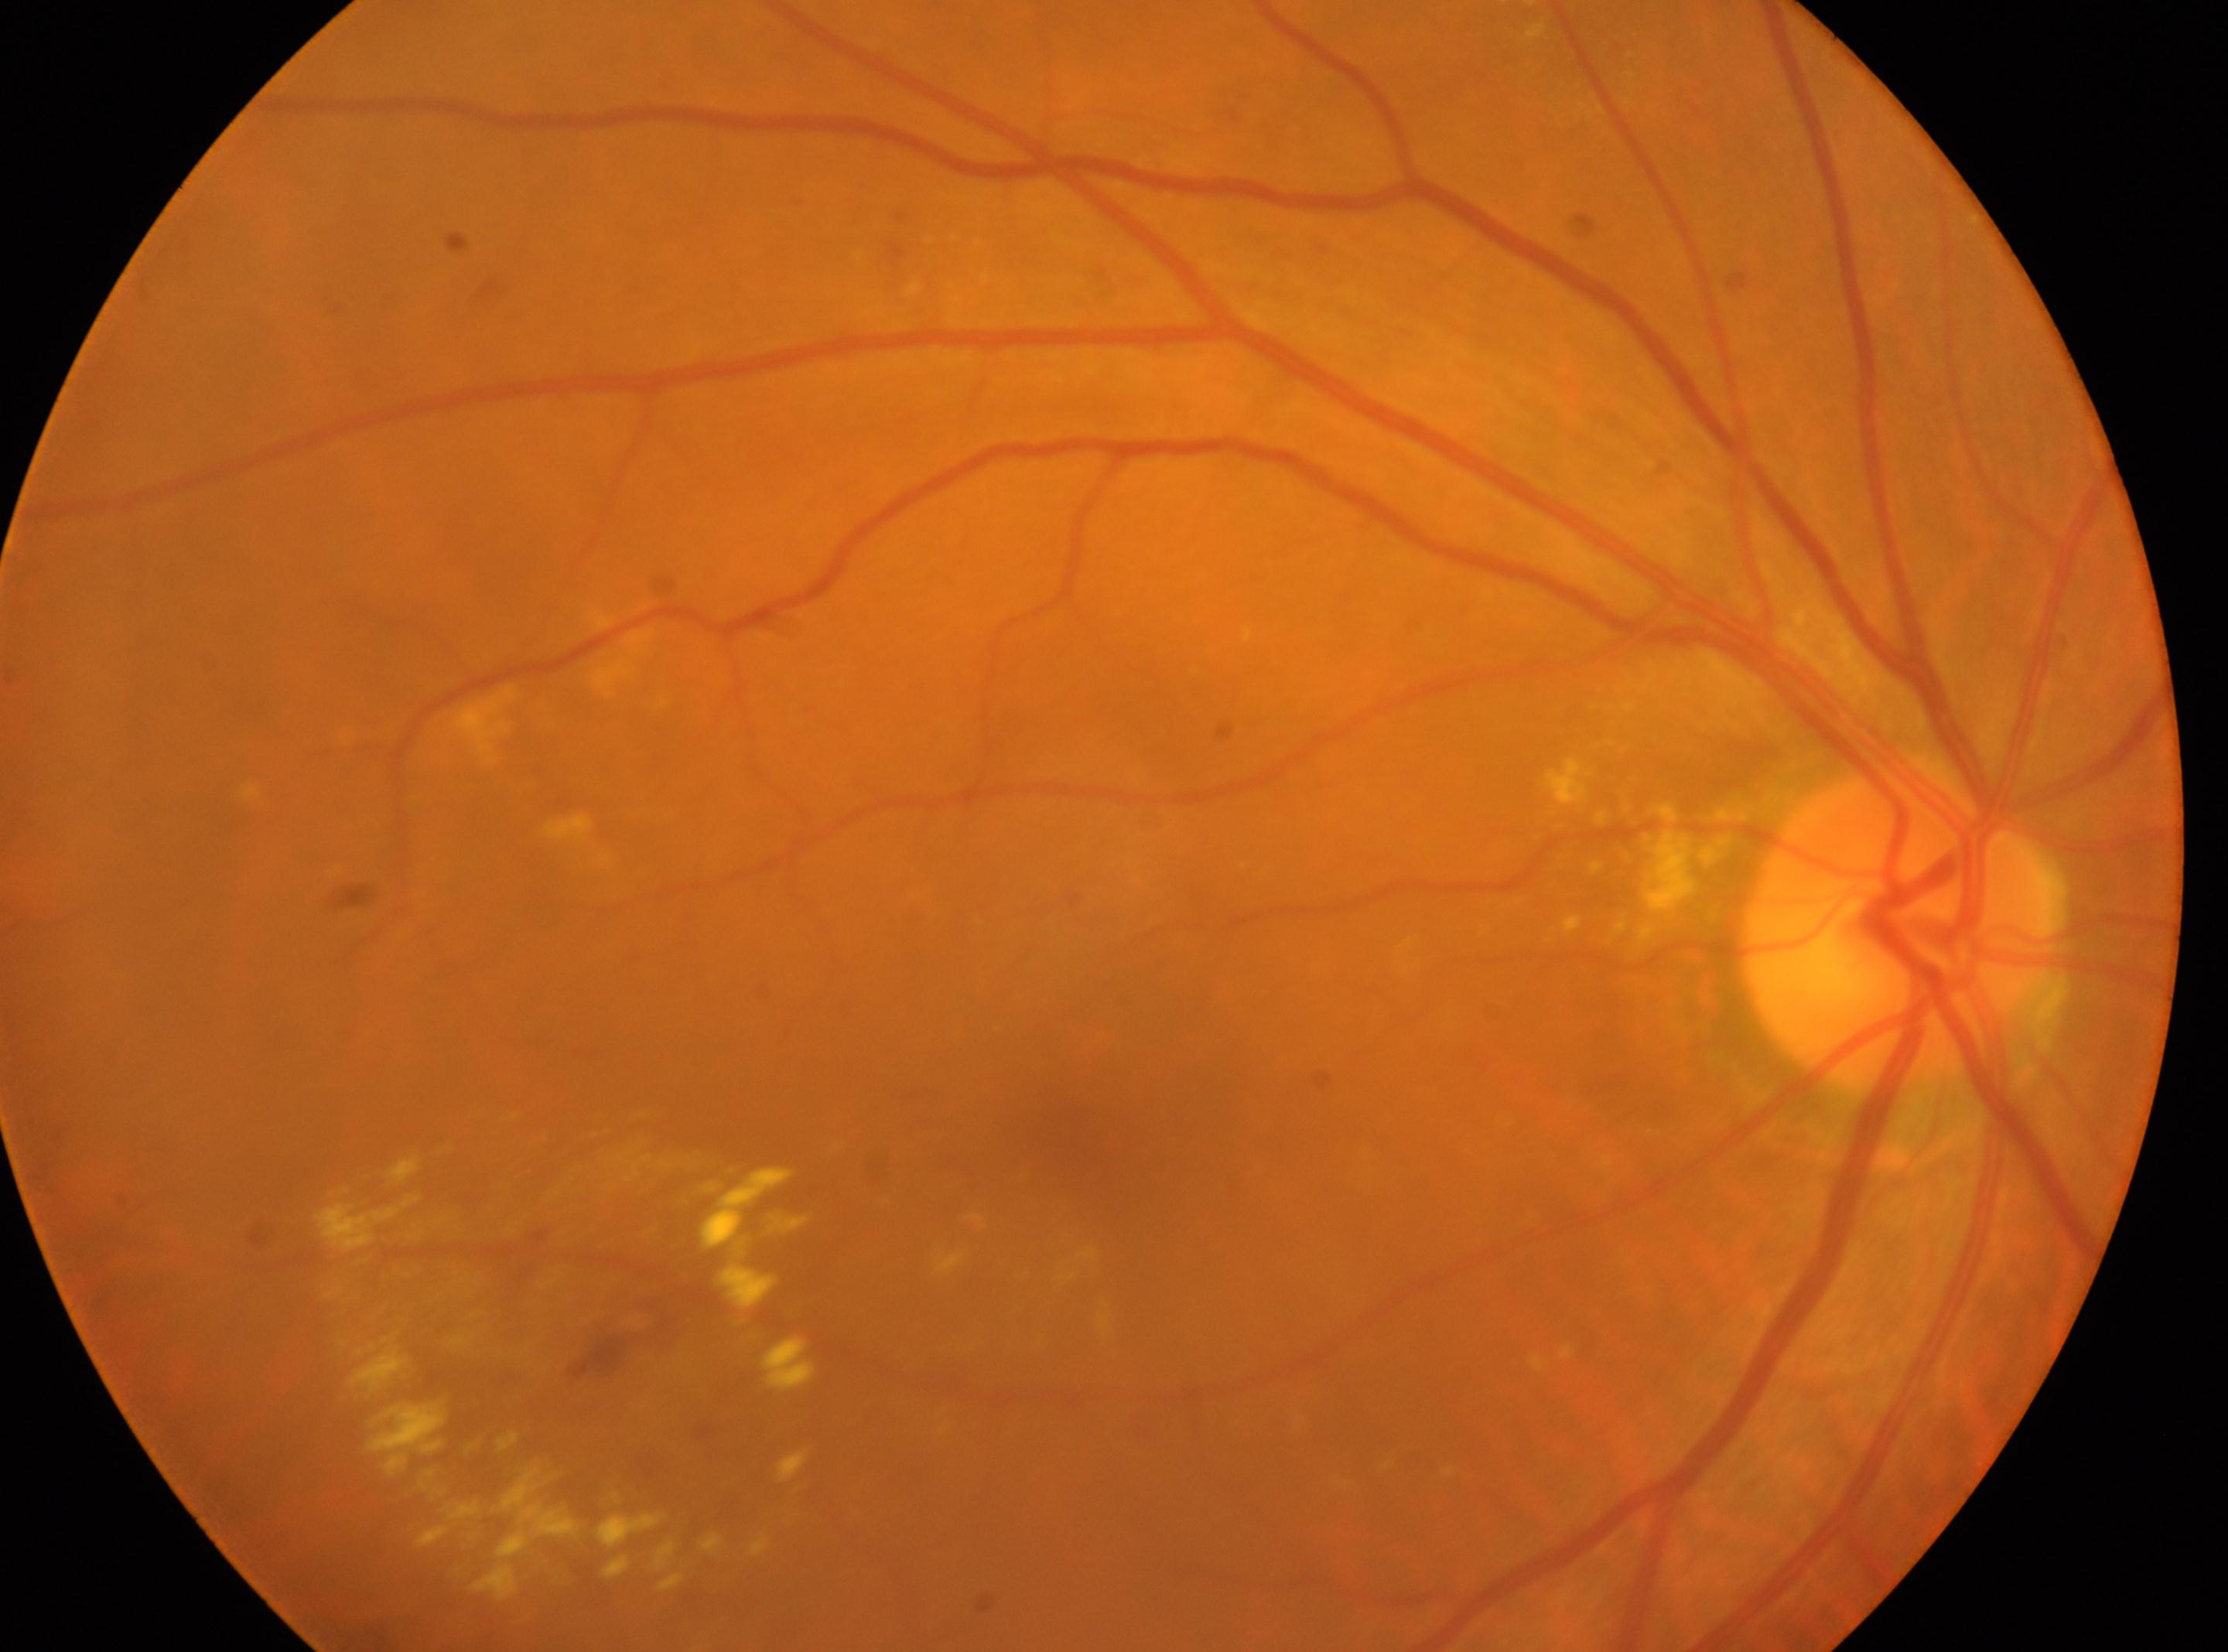

diabetic retinopathy severity = 2 — more than just microaneurysms but less than severe NPDR, laterality = the right eye, fovea centralis = (1088, 1132), optic disc center = (1898, 930).